Fundus photo taken with a portable handheld camera, 2212 by 1659 pixels — 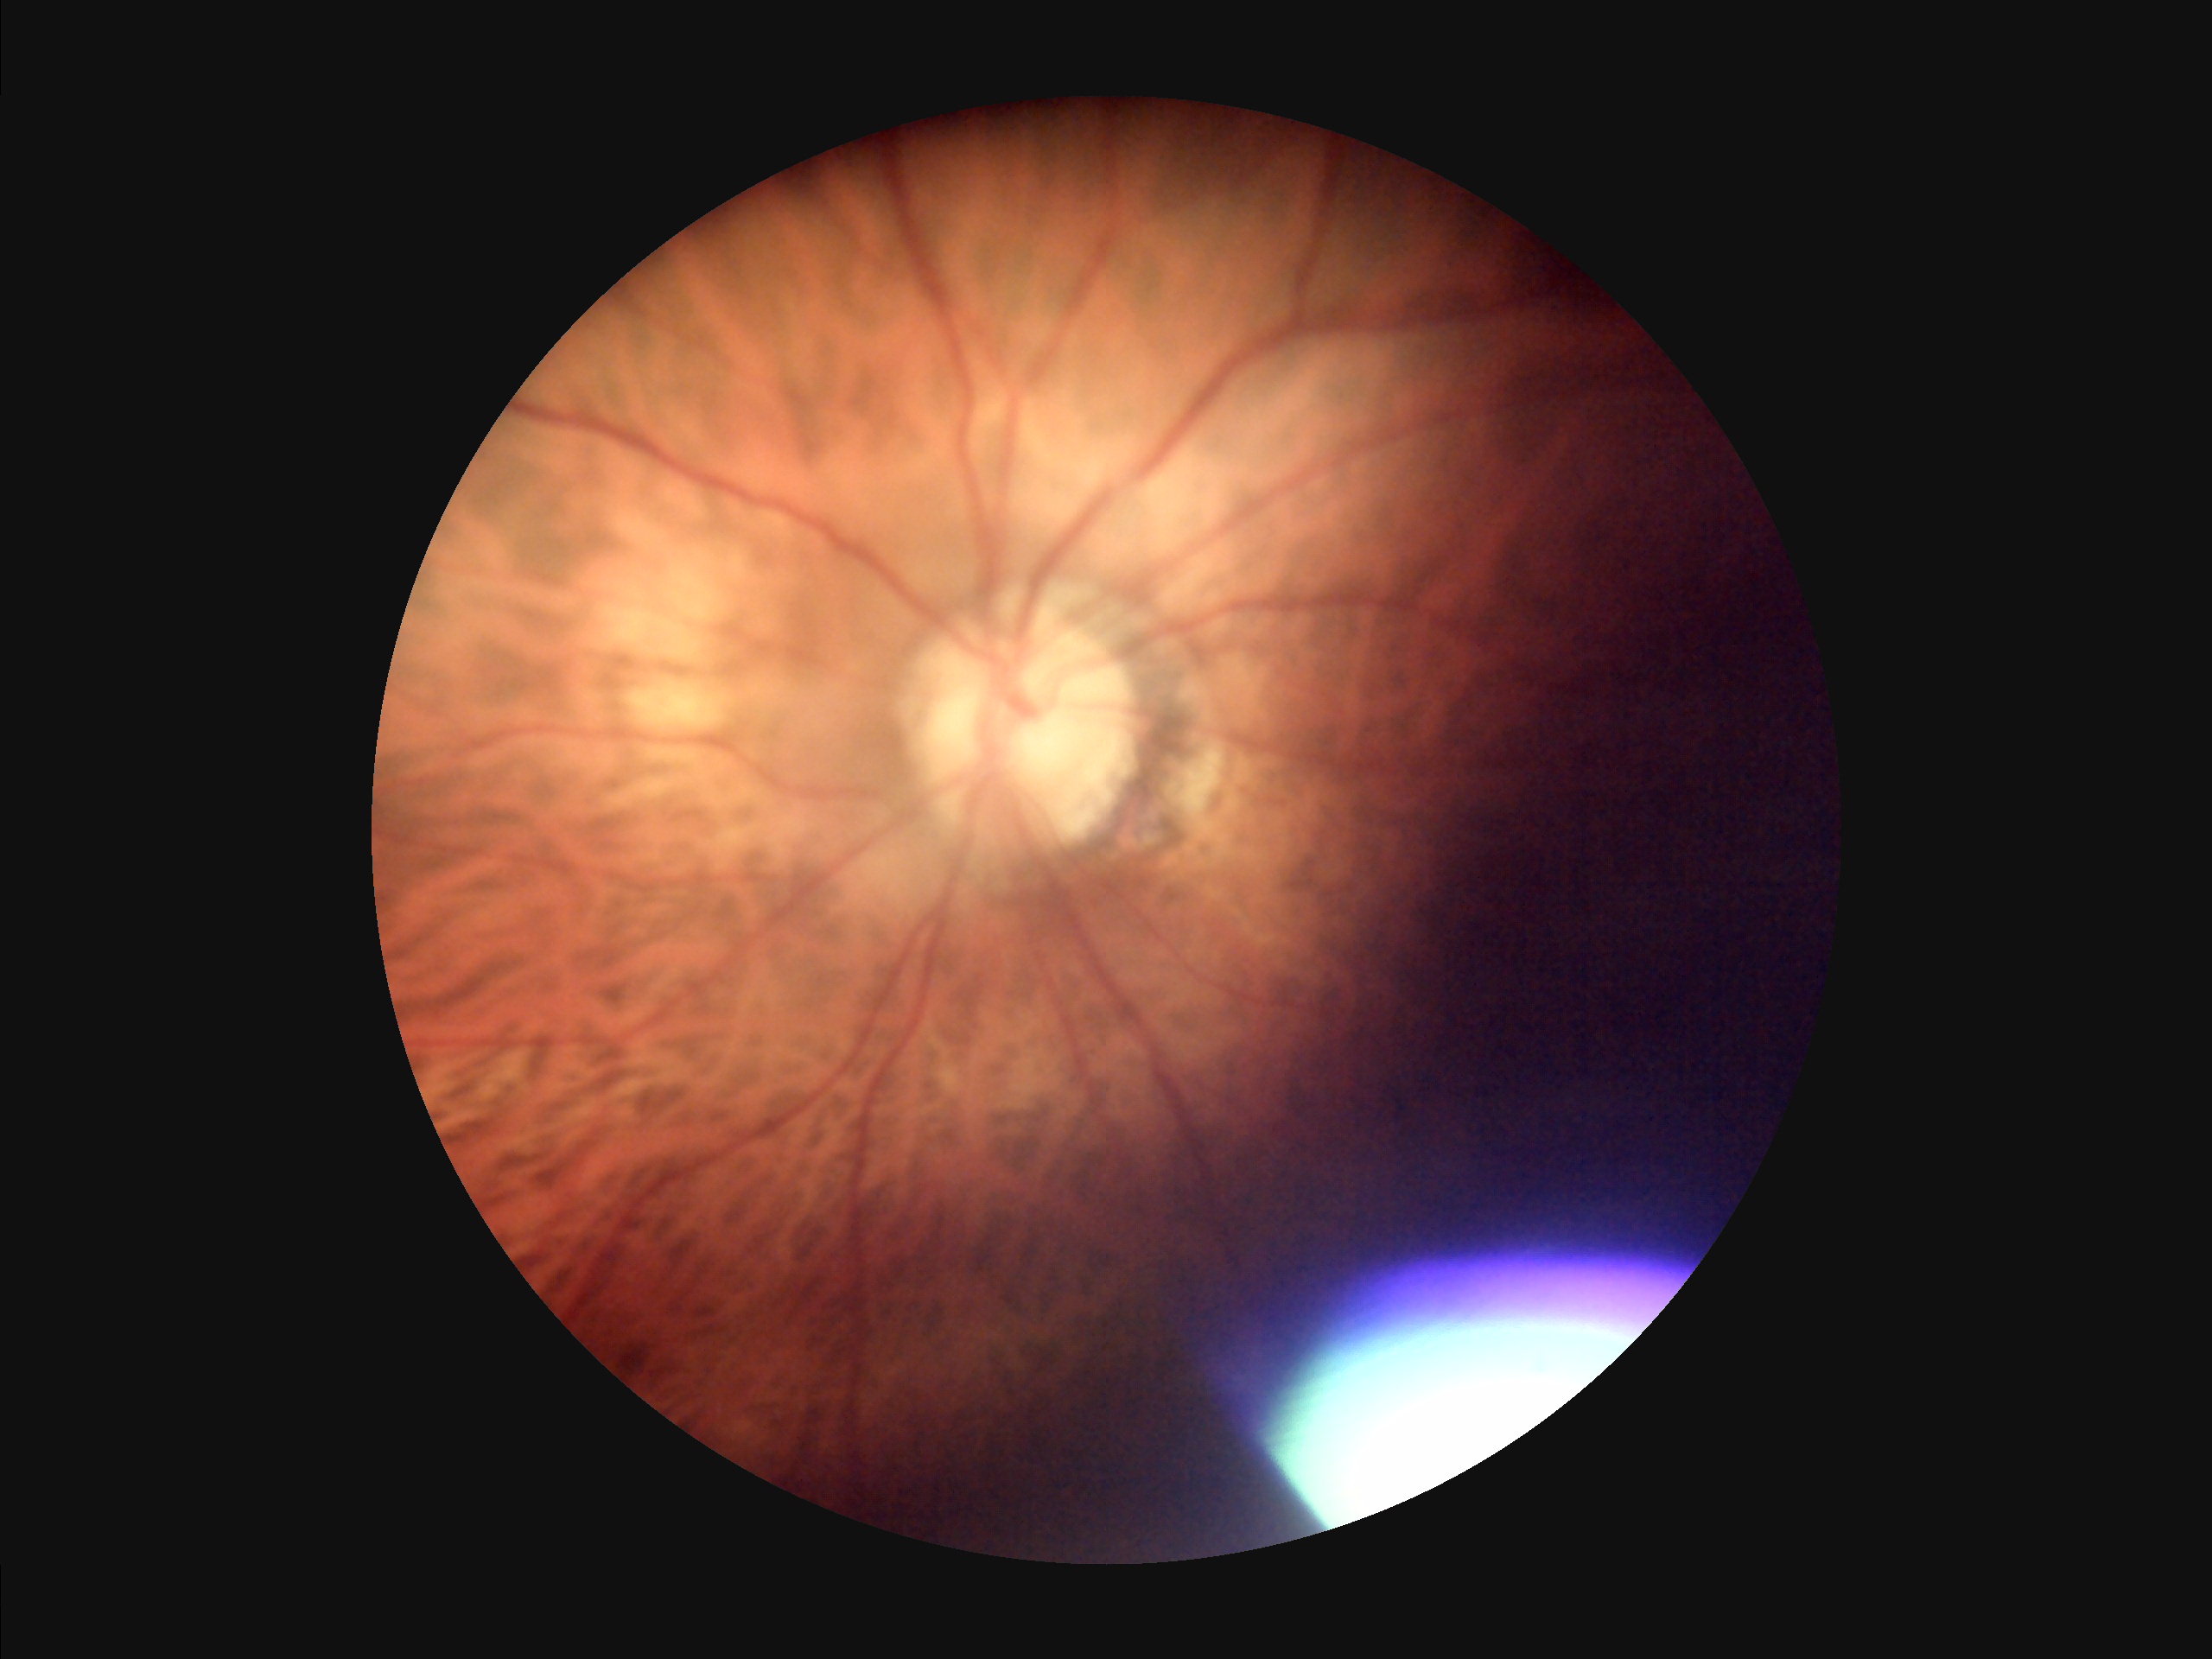
Clarity = in focus; Overall quality = poor; Illumination = uneven; Contrast = good.